Infant wide-field fundus photograph · captured with the Clarity RetCam 3 (130° field of view) · 640 x 480 pixels:
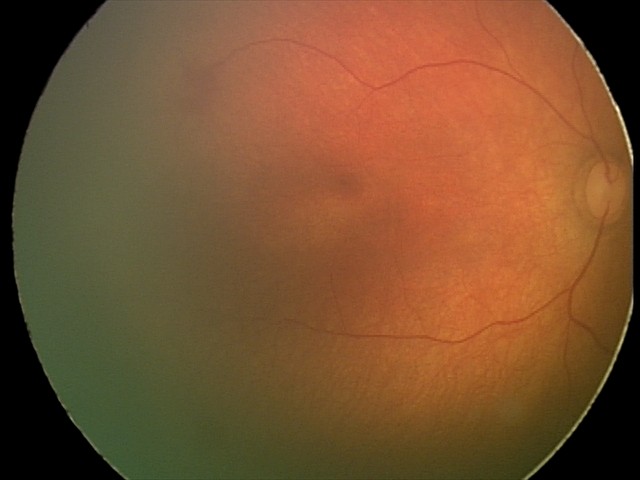 Q: What was the screening finding?
A: physiological retinal finding